2048x1536. 45-degree field of view.
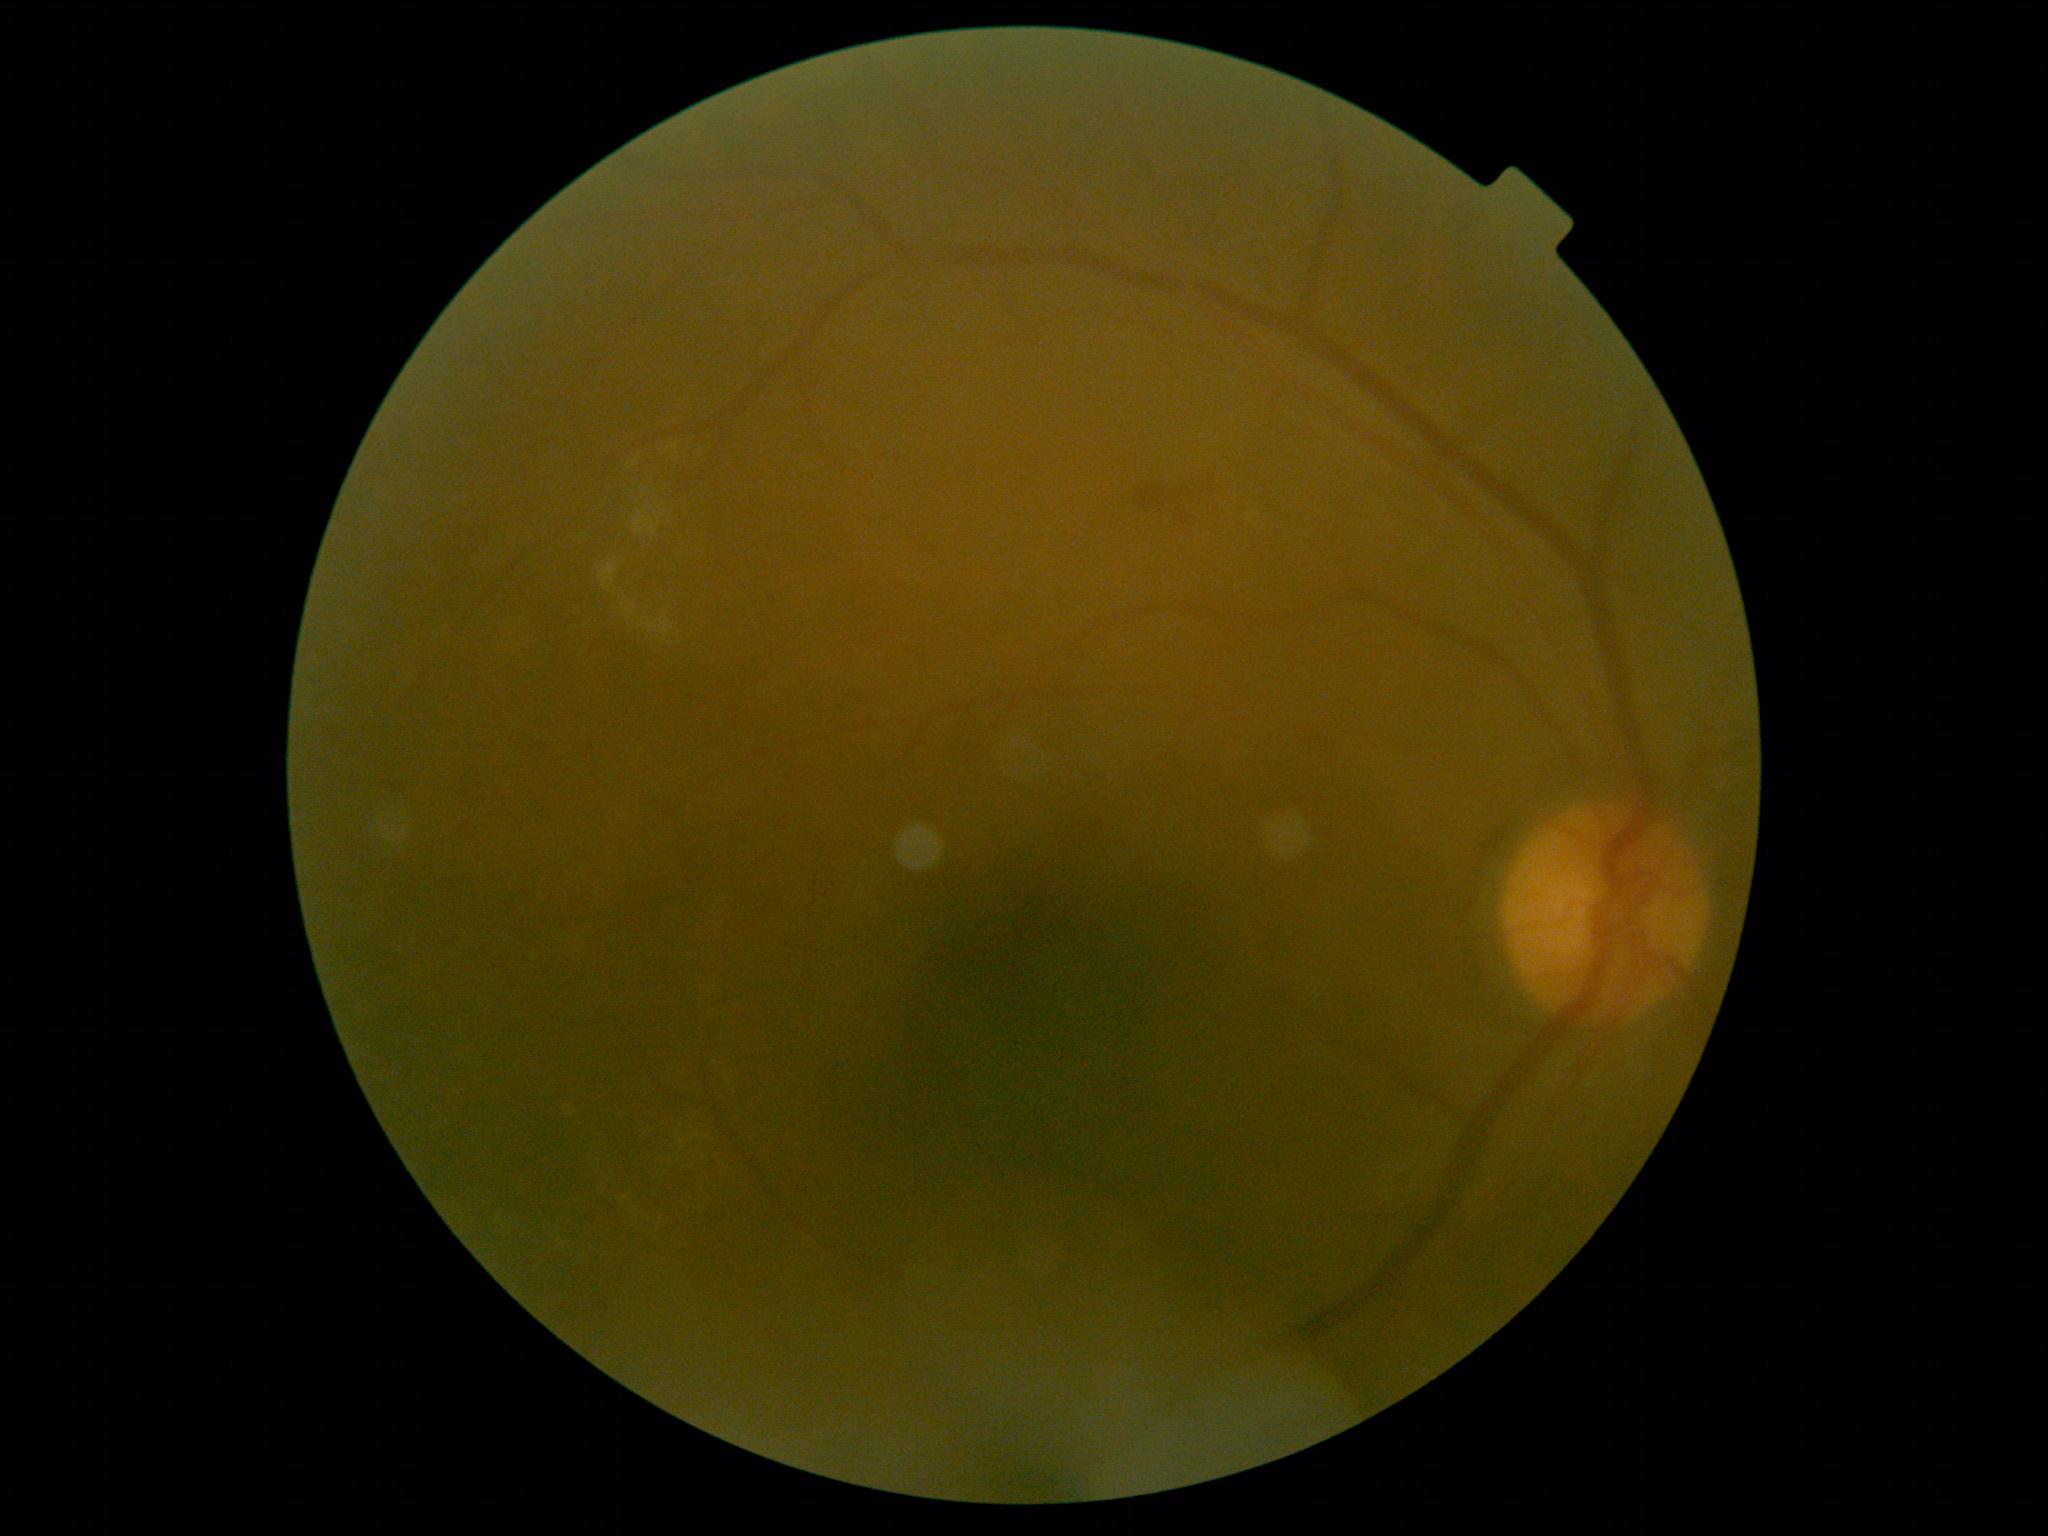

DR class=non-proliferative diabetic retinopathy, retinopathy=grade 2 (moderate NPDR).